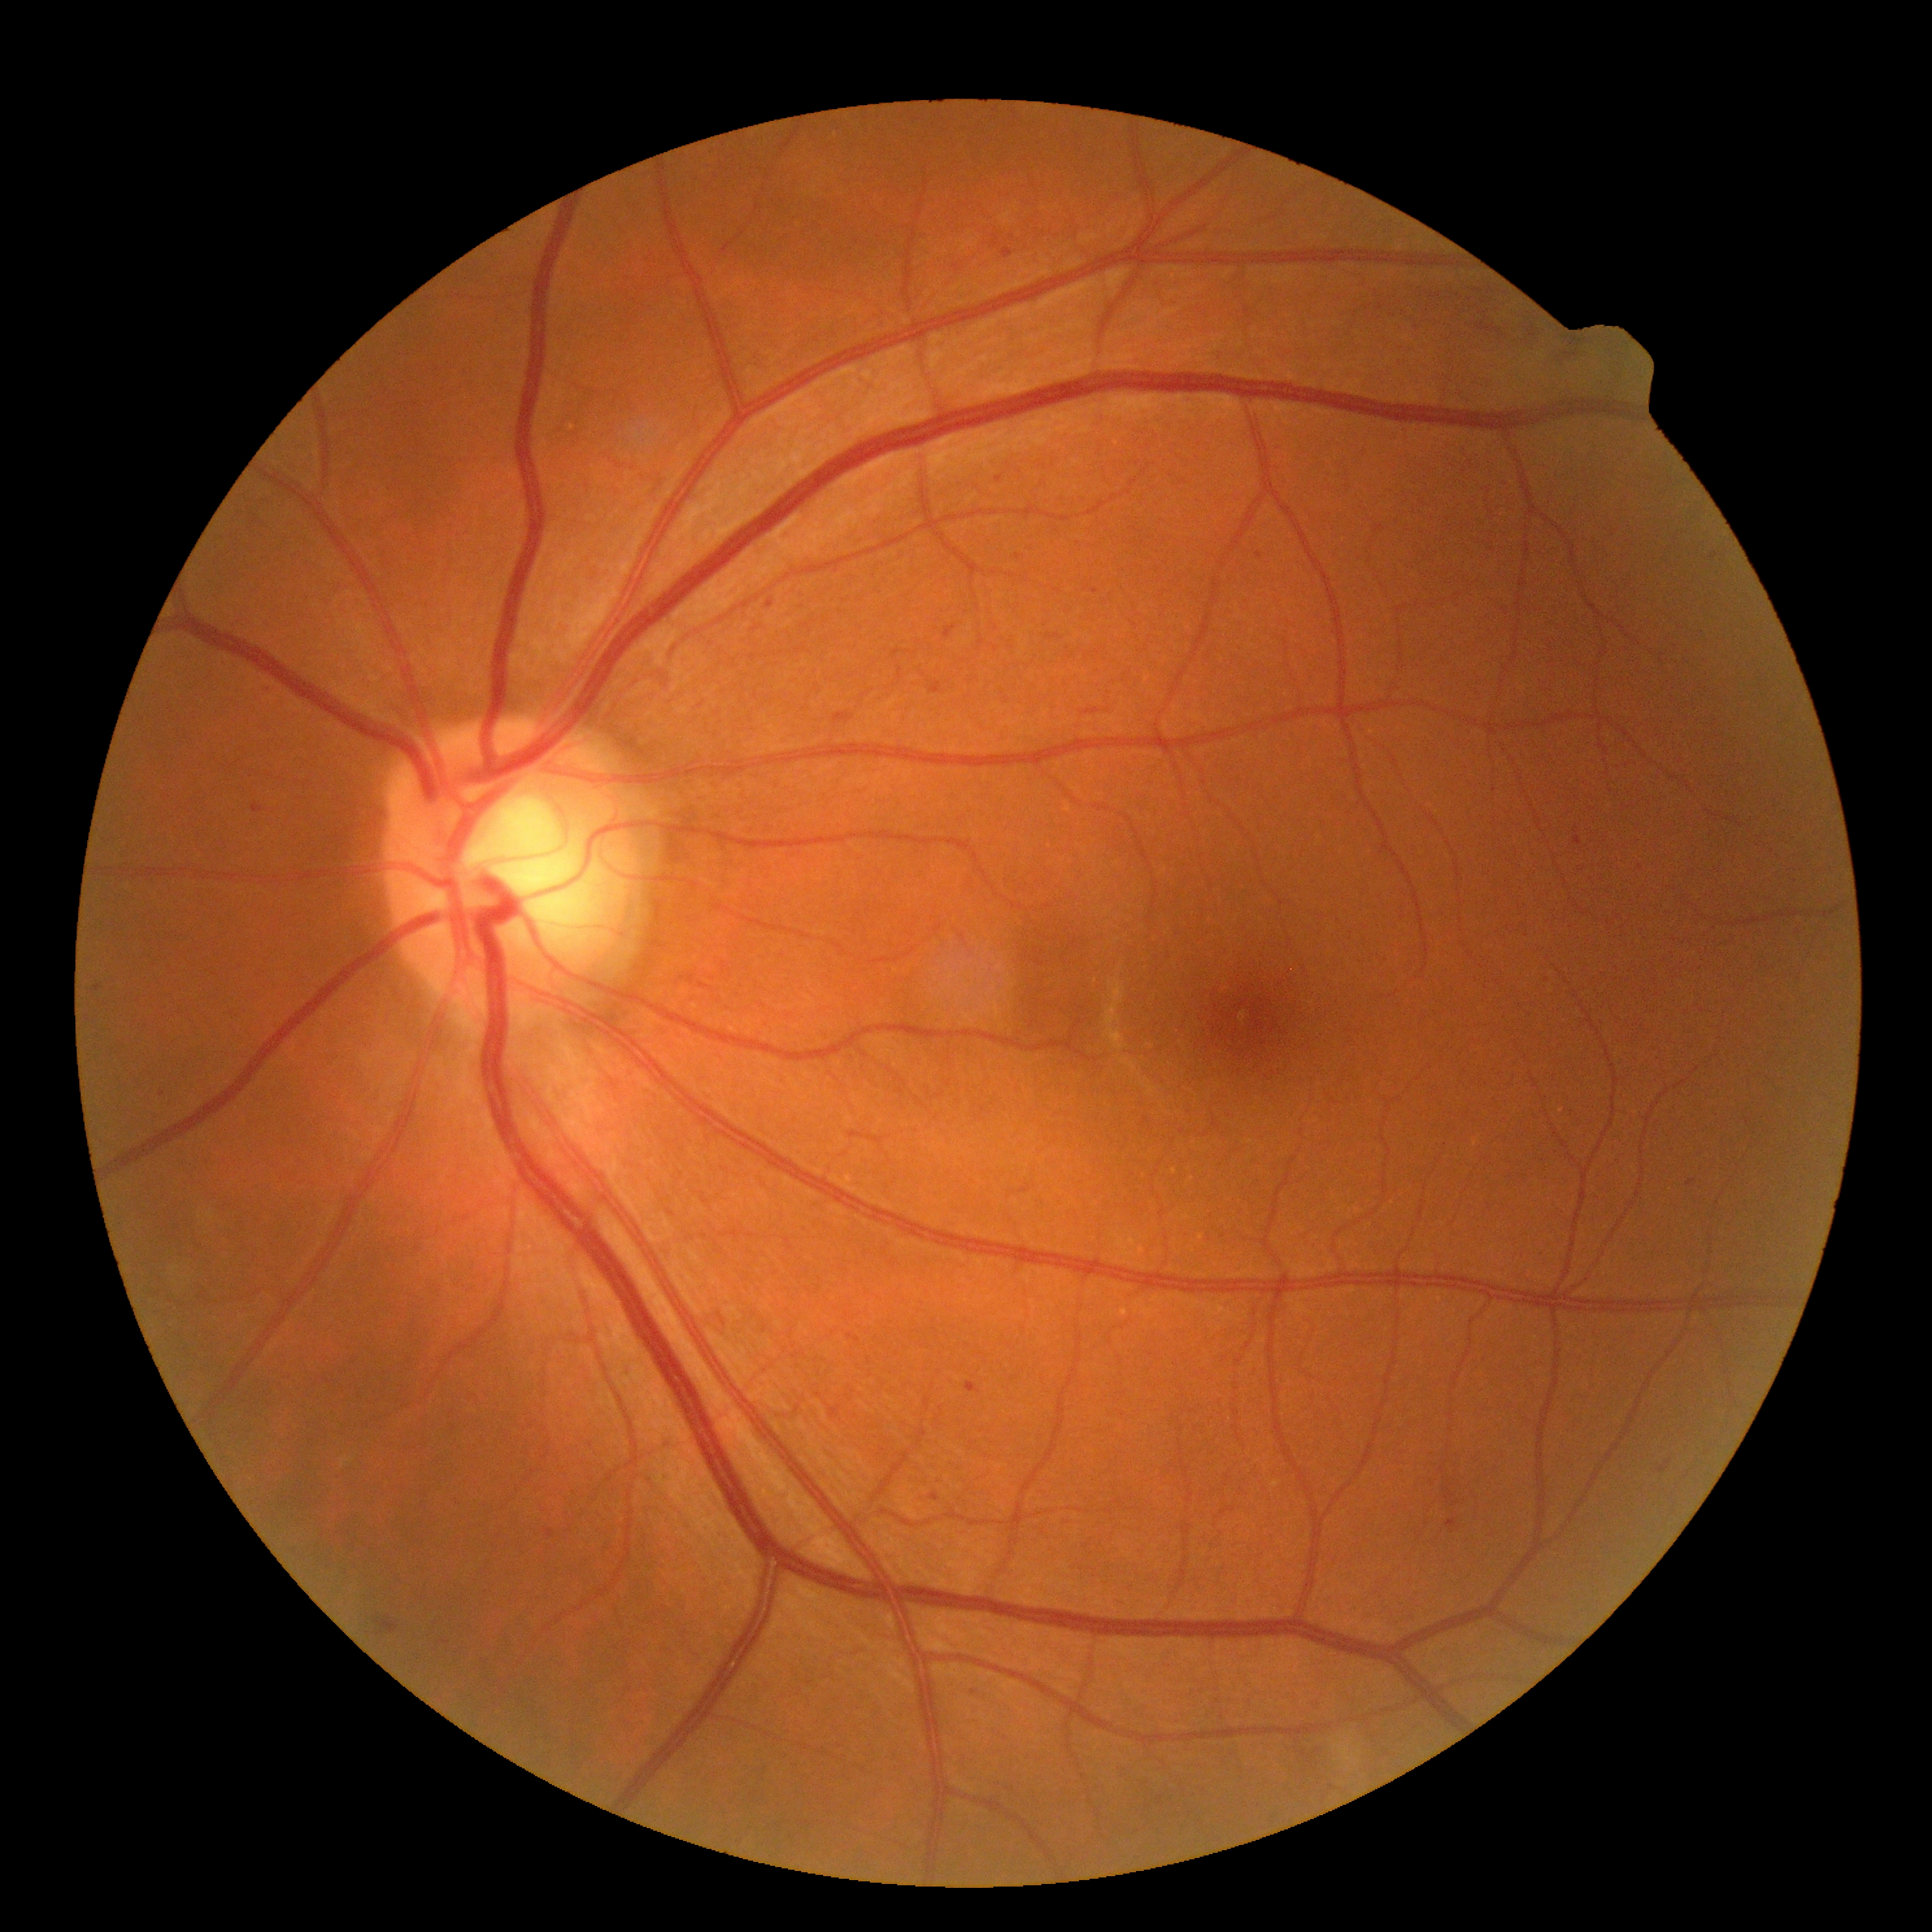
diabetic retinopathy: grade 2 (moderate NPDR).